Macula-centered. 1932x1932px.
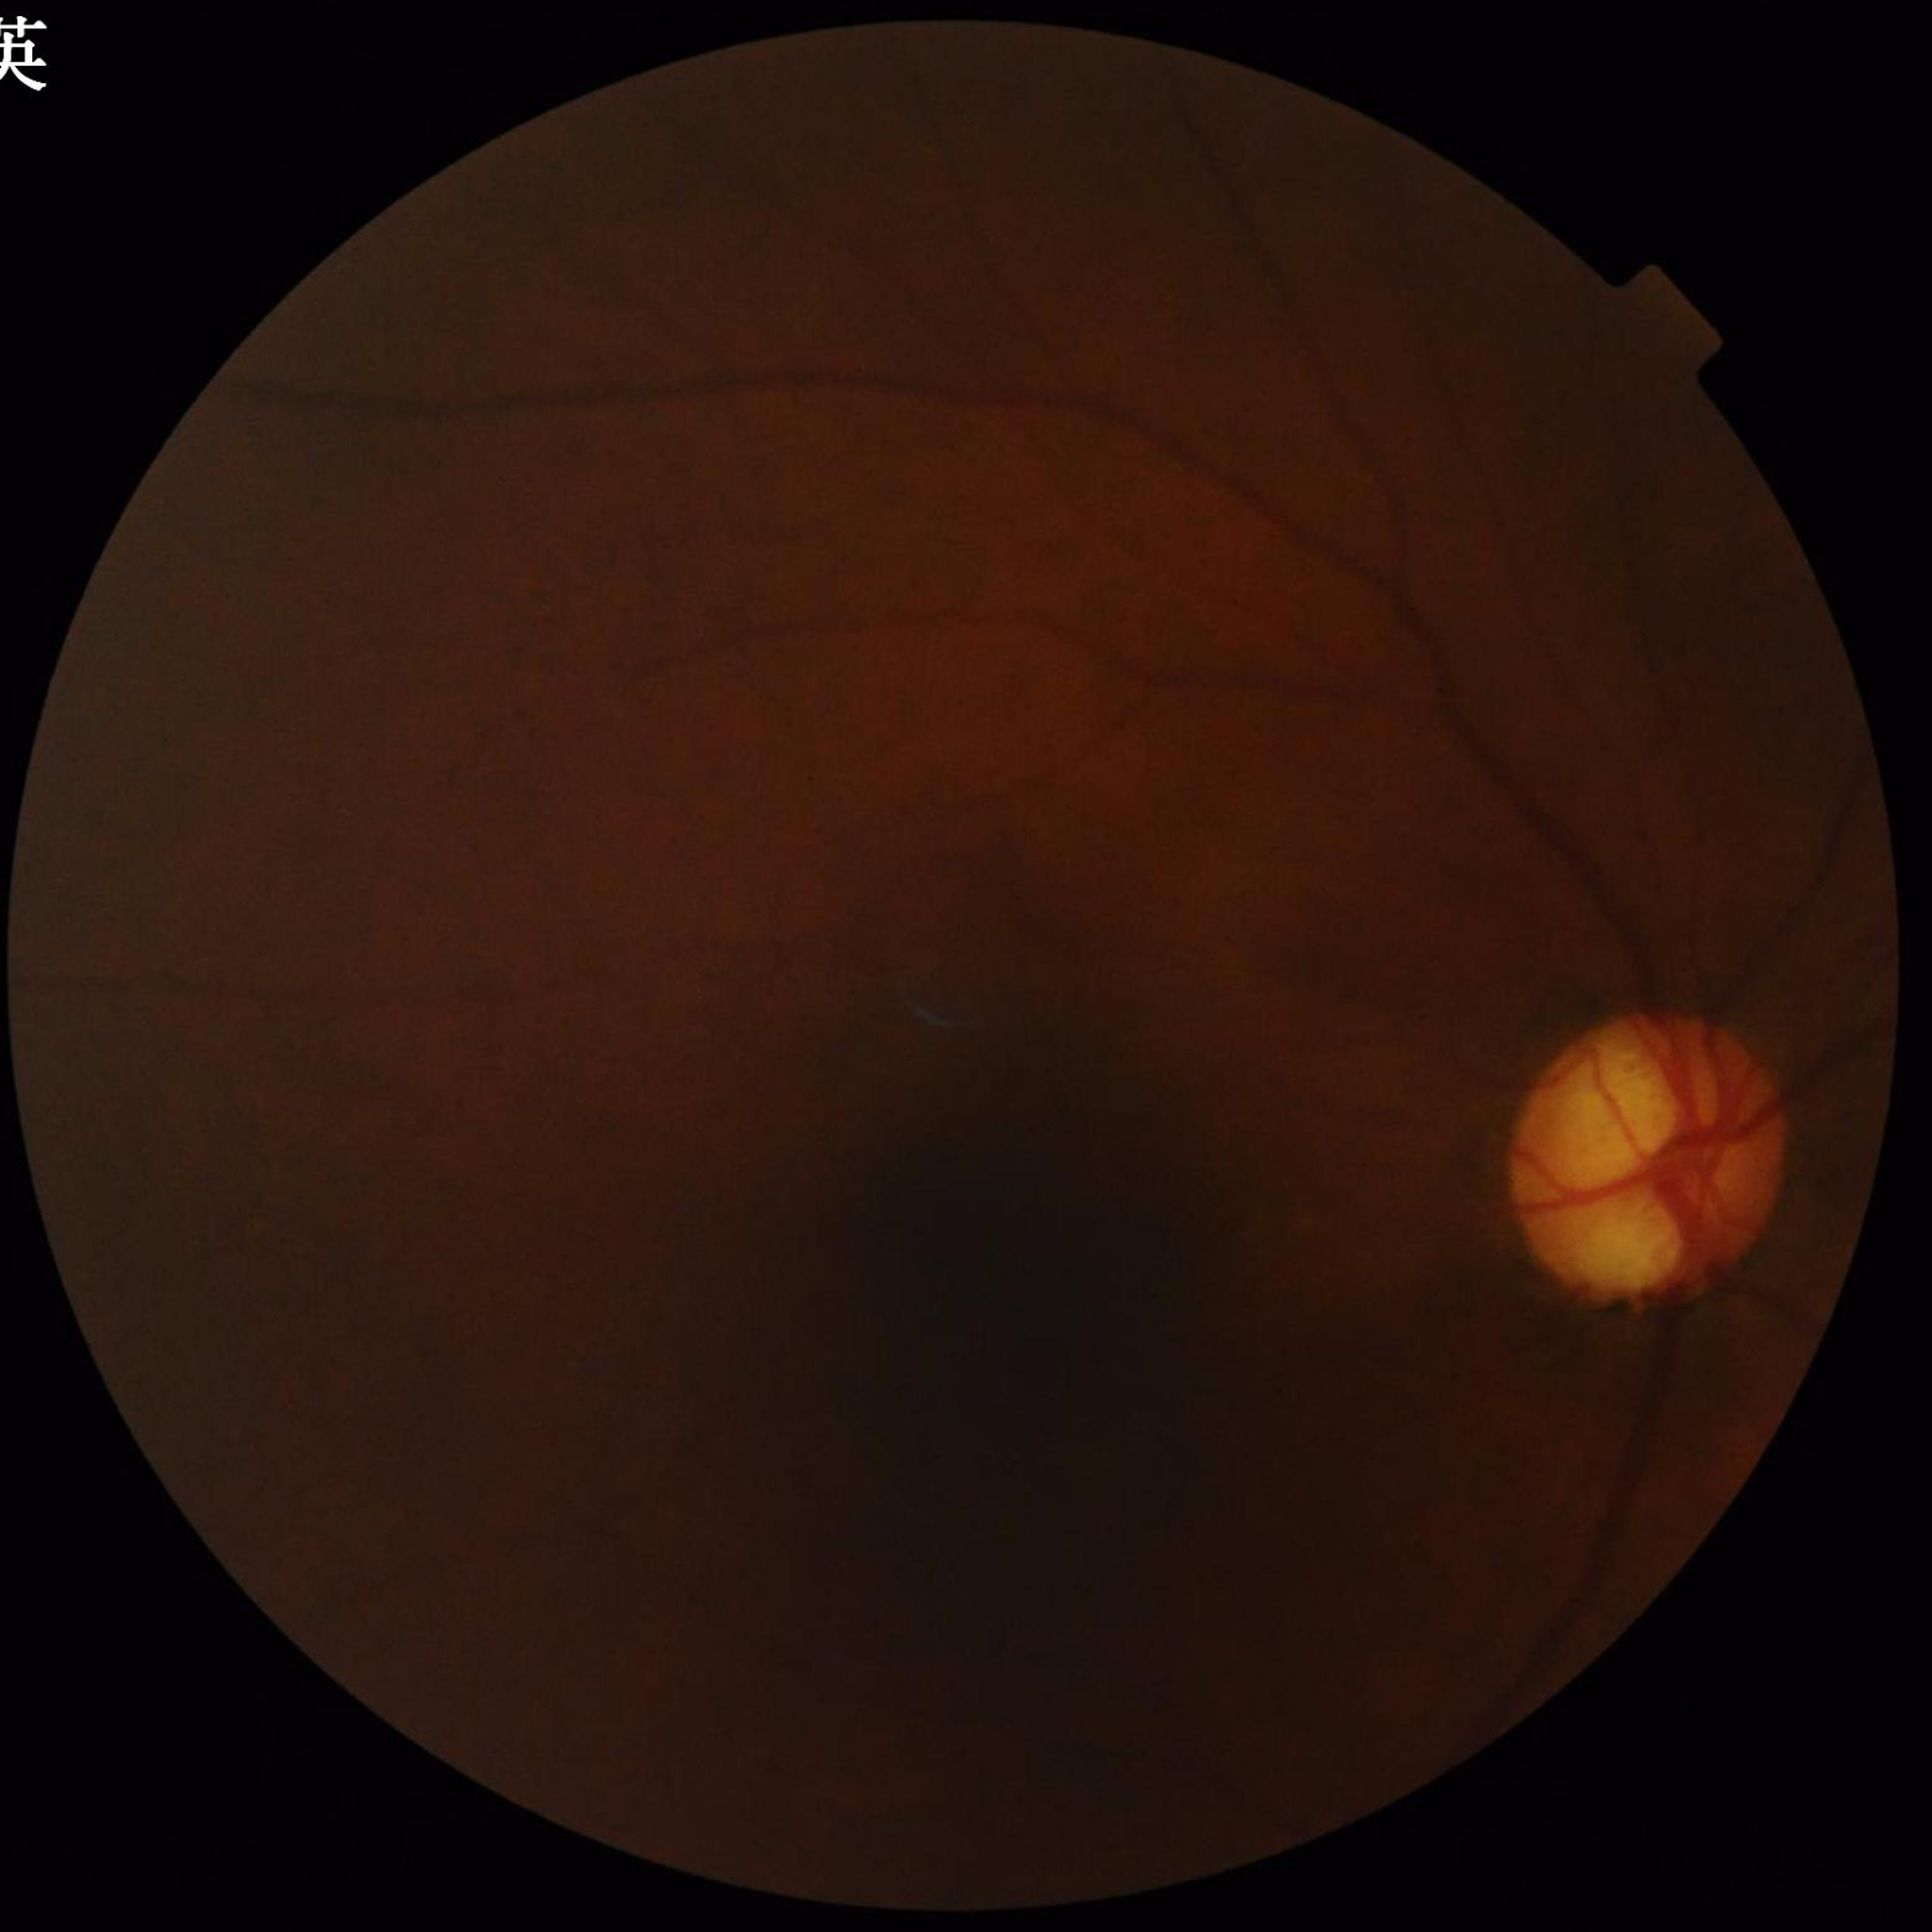
Diagnosed with glaucoma. Quality assessment: low contrast, illumination/color distortion present, blur present.